848 x 848 pixels — 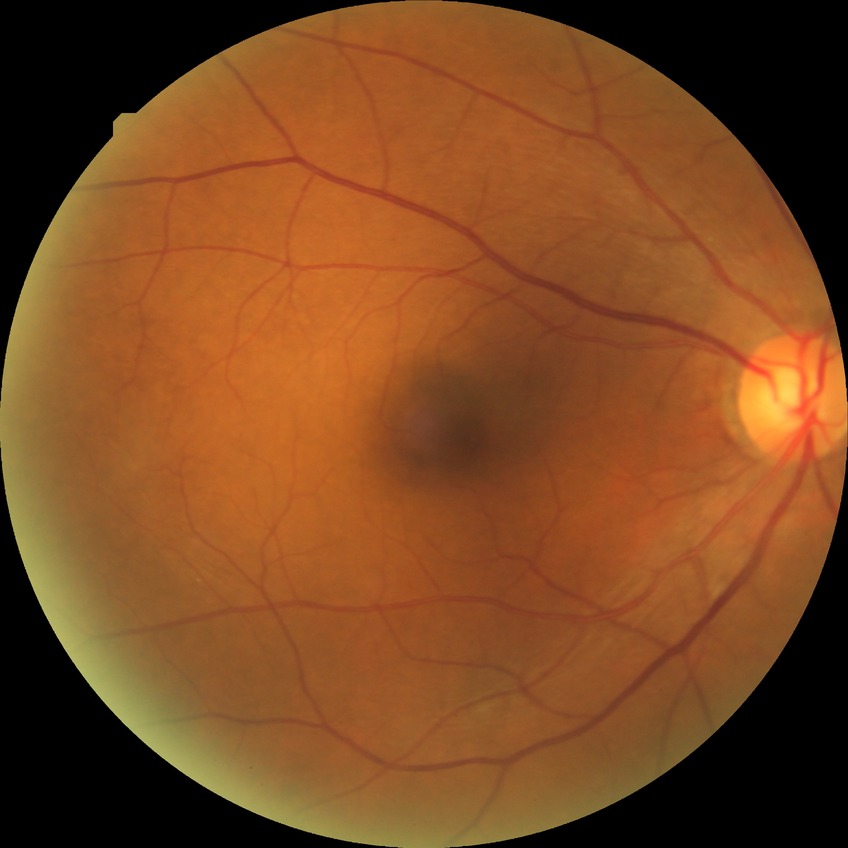
diabetic retinopathy stage = simple diabetic retinopathy.